45° FOV; 2212 by 1659 pixels
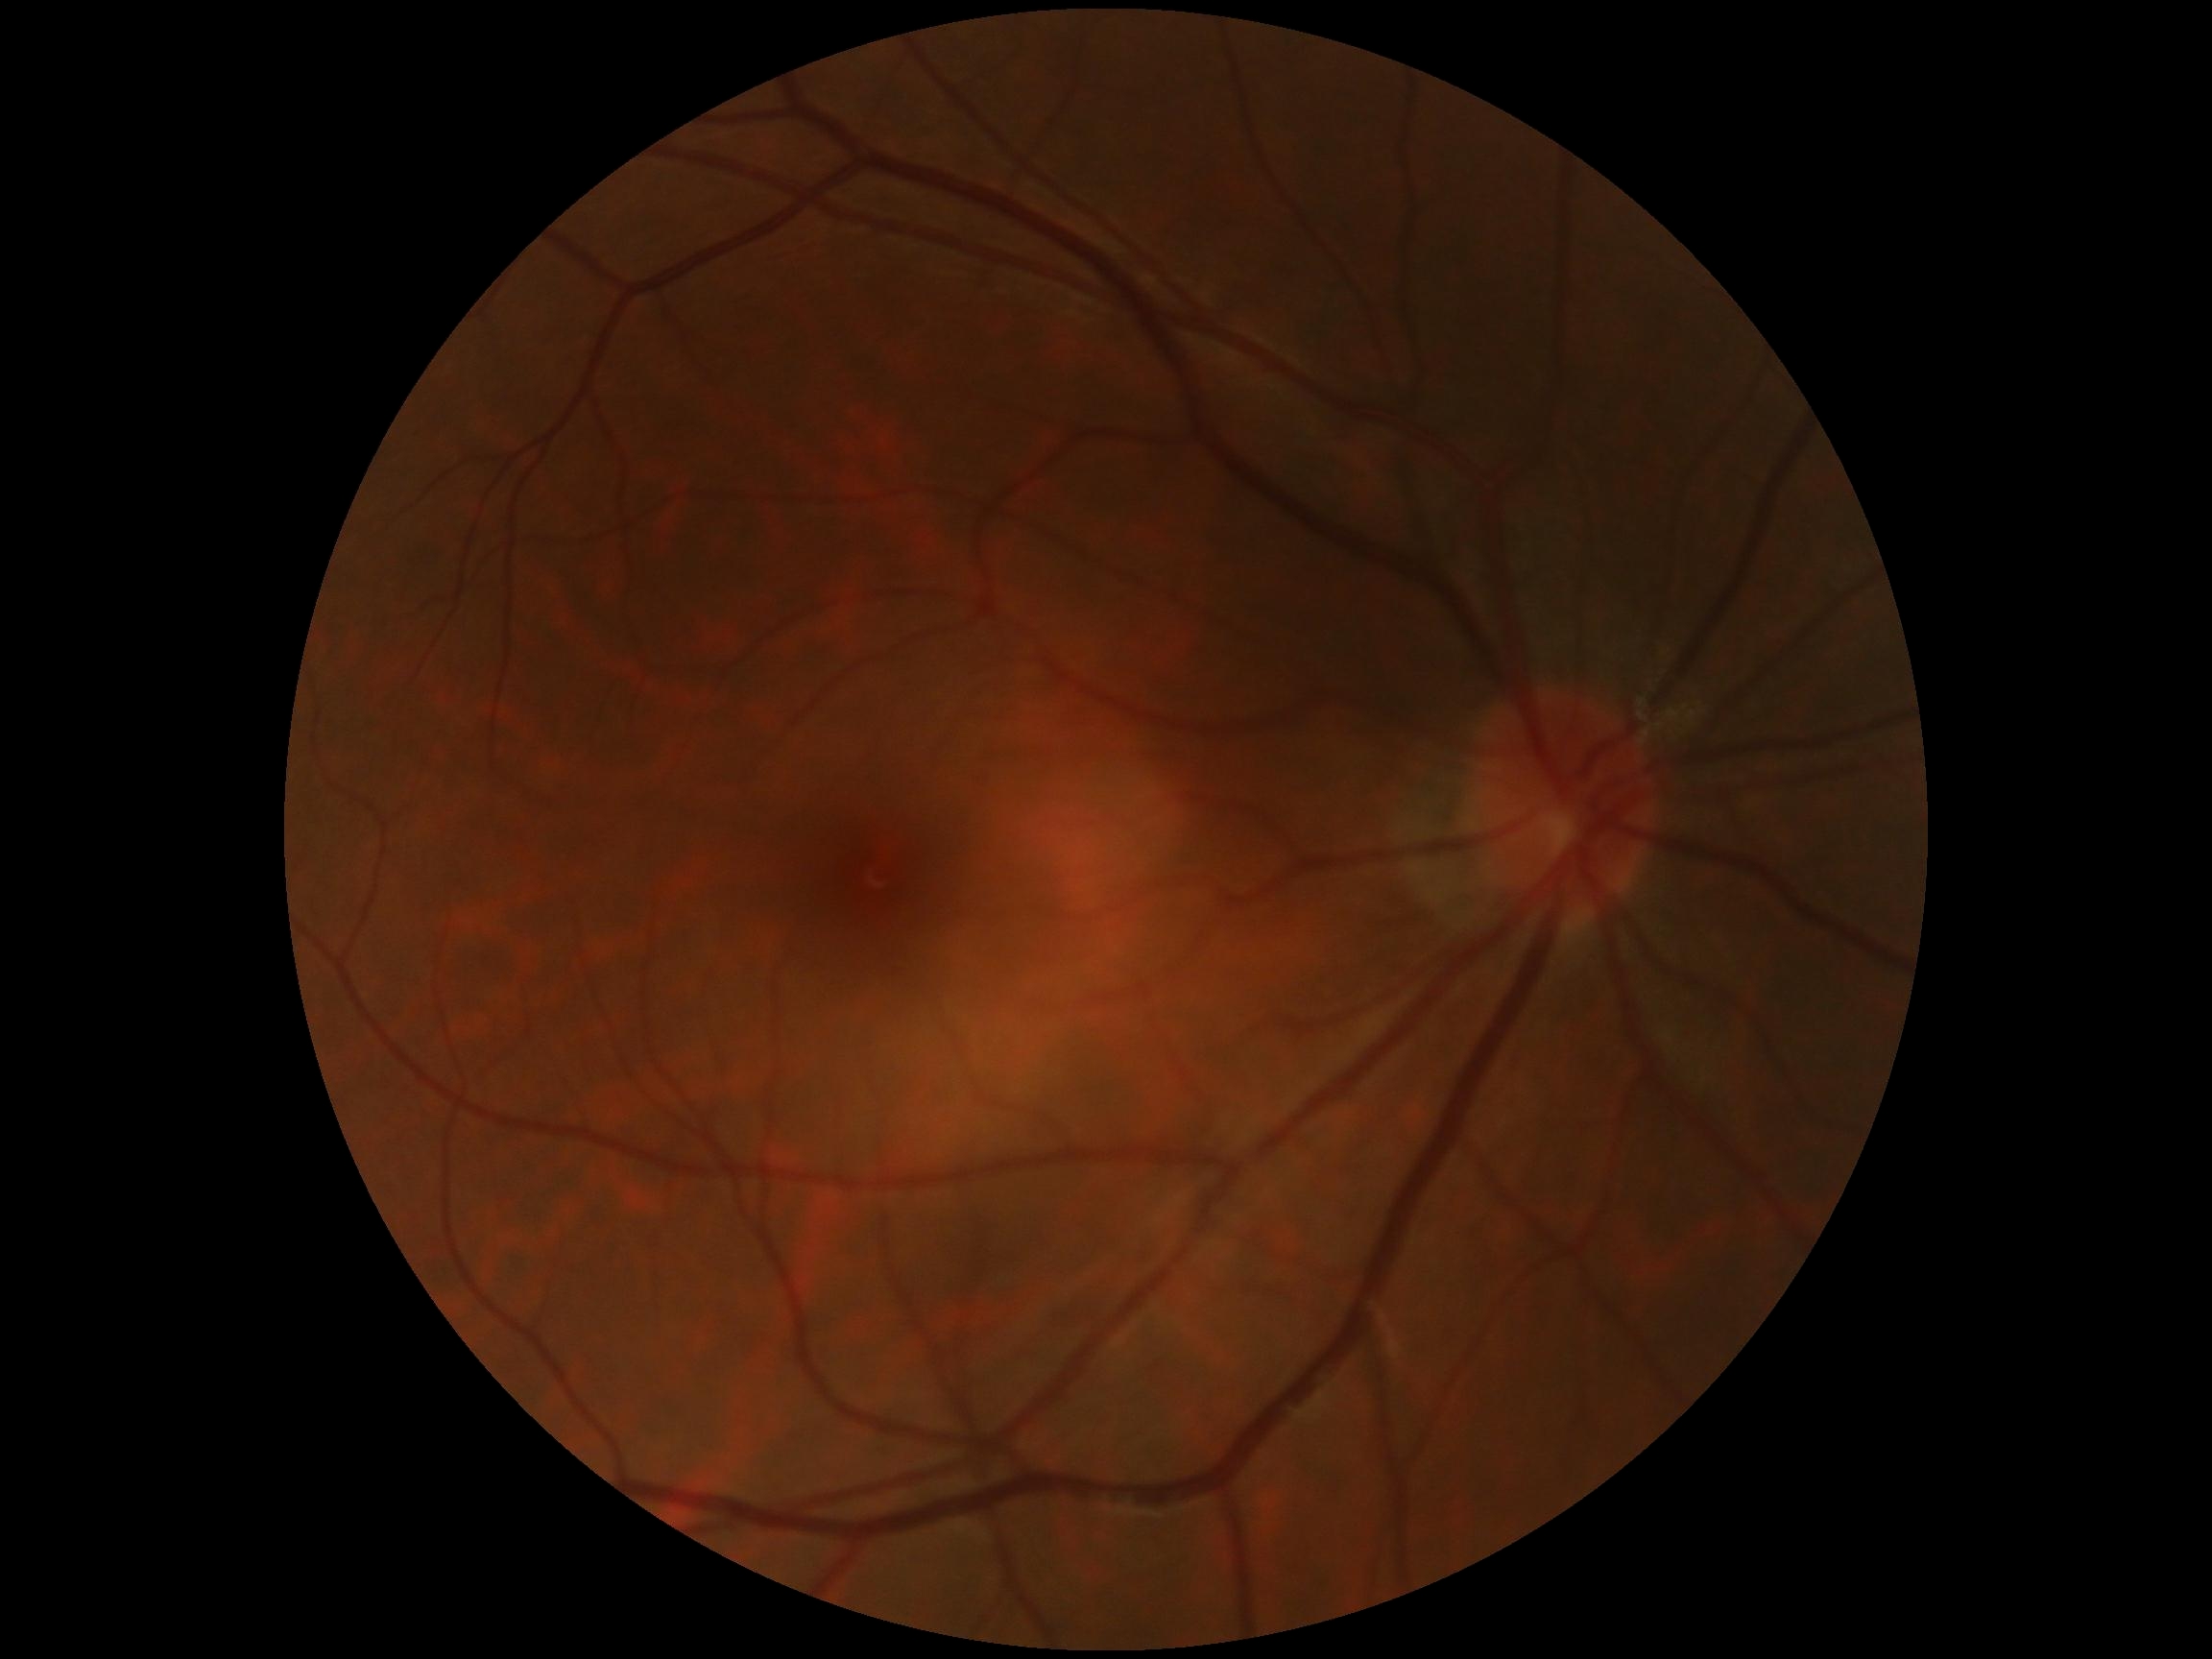
DR stage = 0.